Intraocular pressure 12 mmHg (pneumatic tonometry). 76 years old. Non-mydriatic. Axial length 21.93 mm. Autorefraction: sphere +3.75 D, cylinder -3 D, axis 95°: 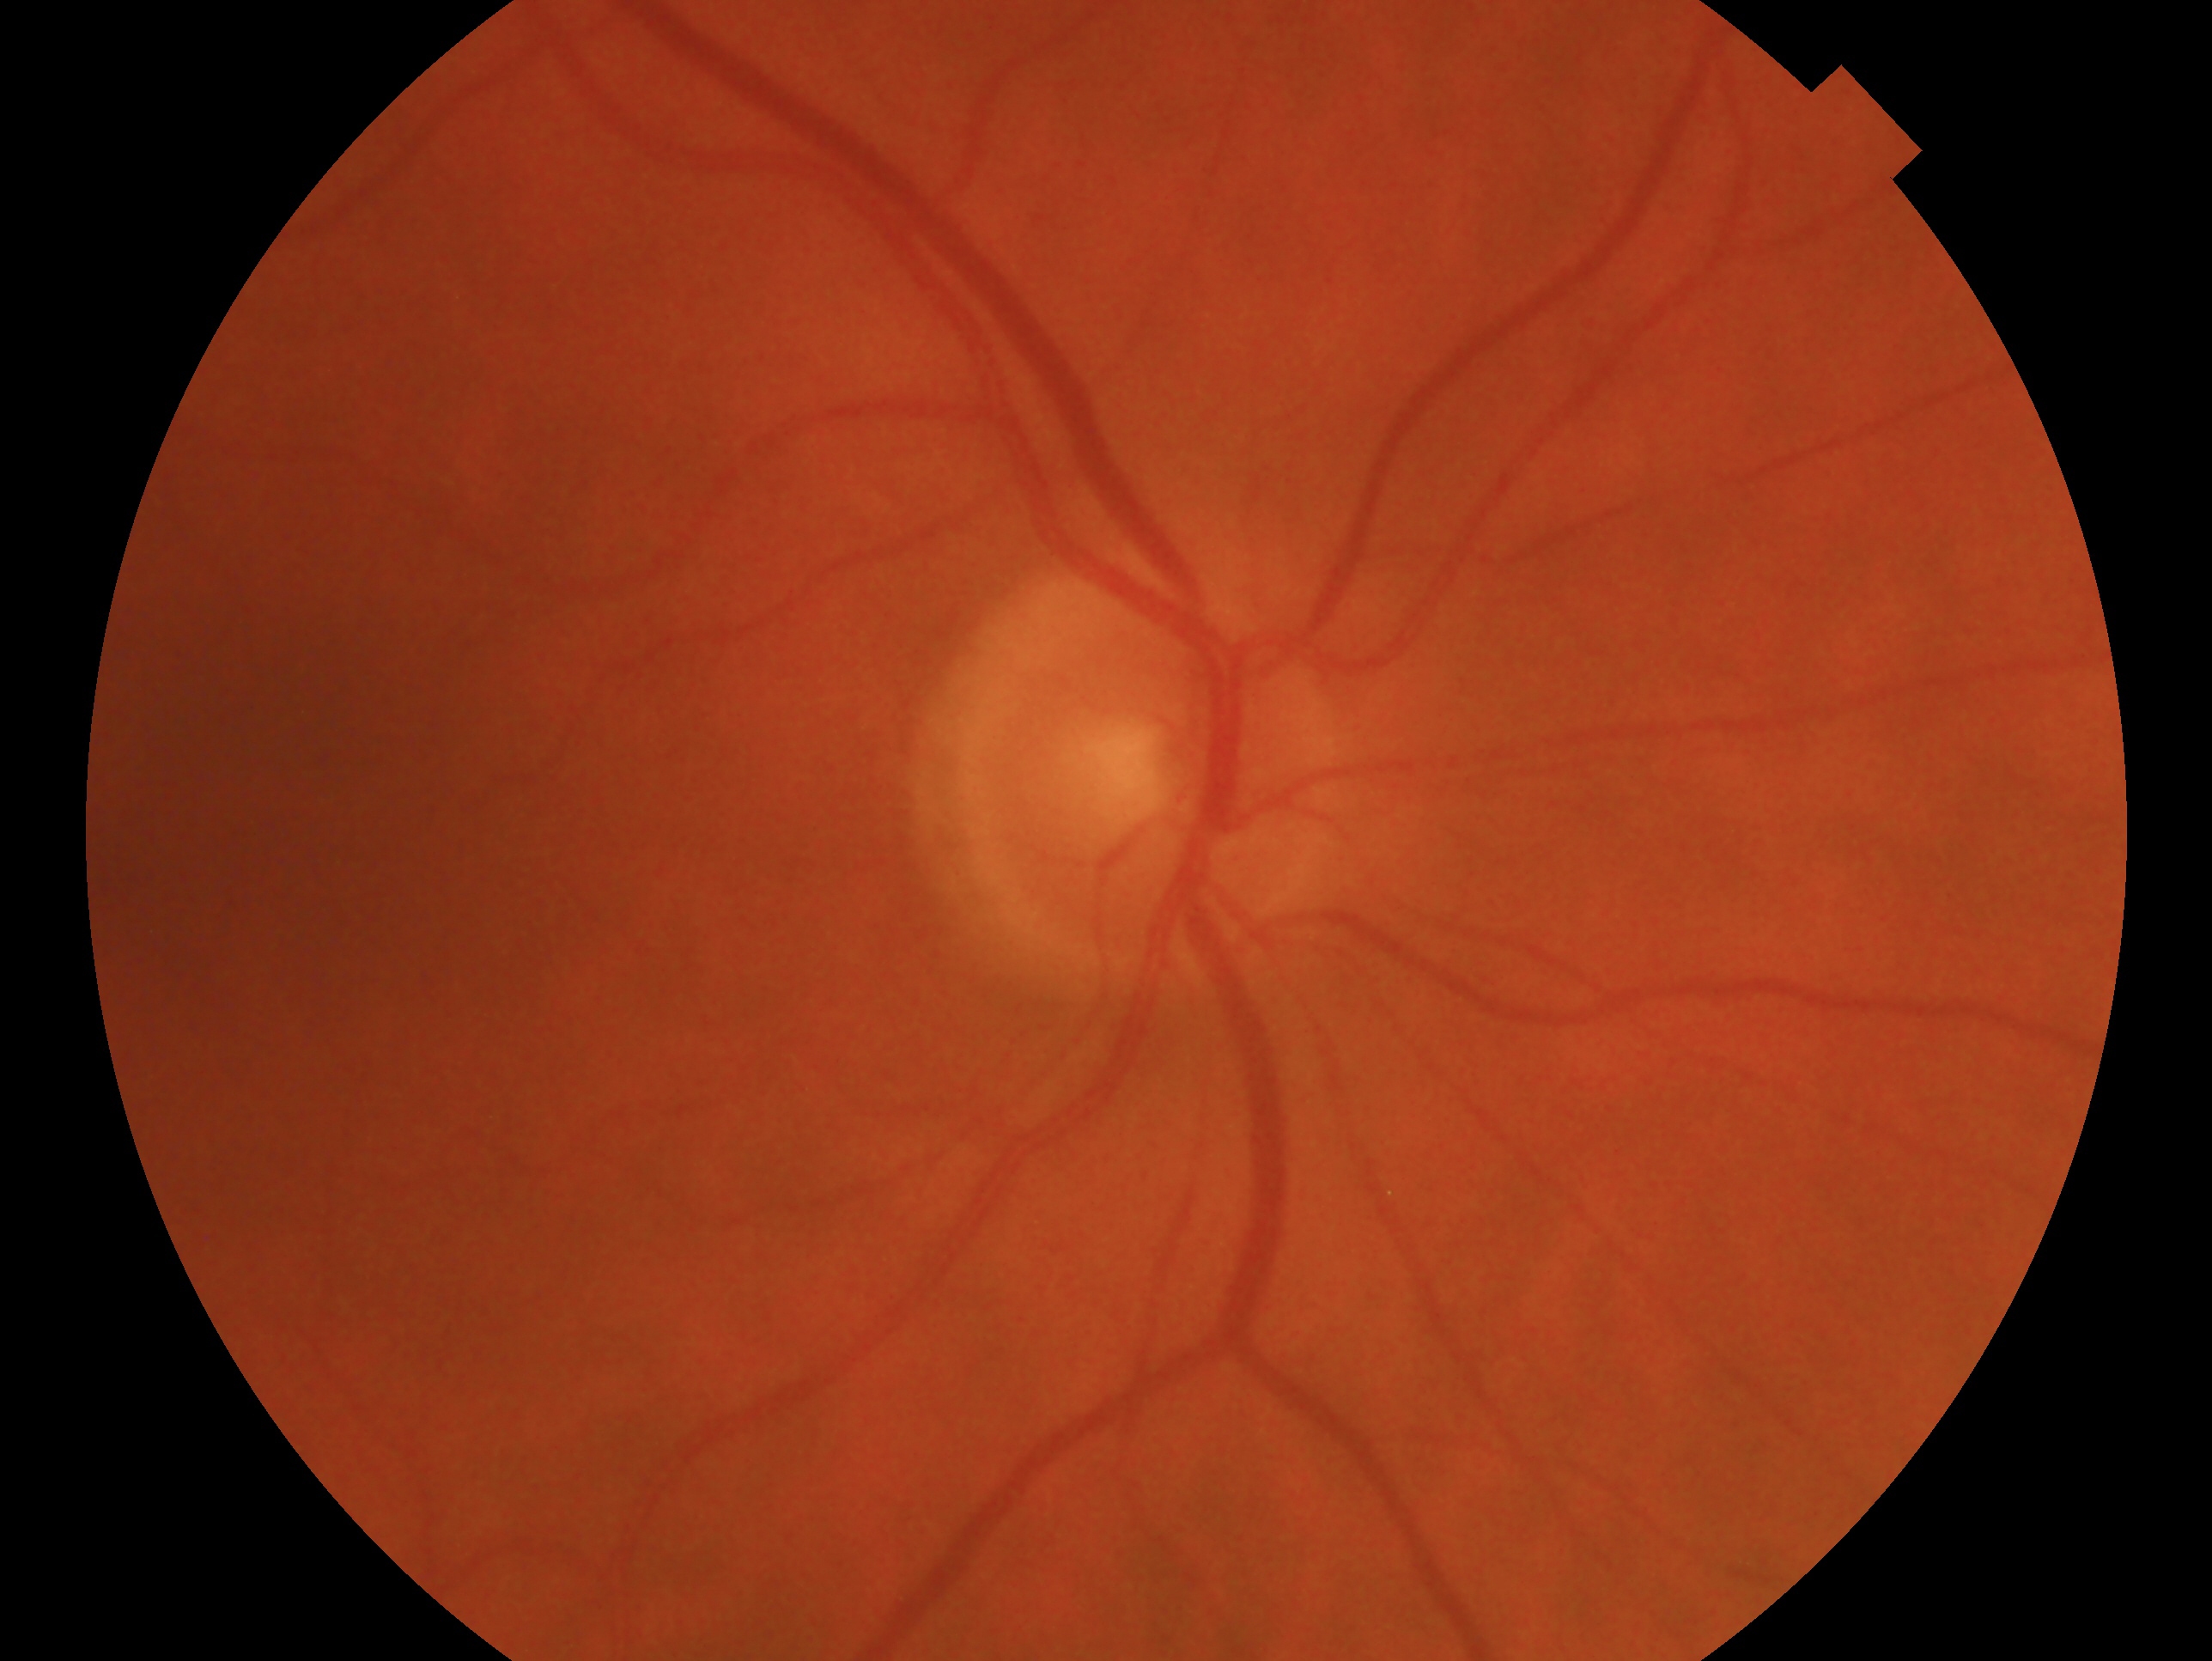 Q: Right or left eye?
A: right eye
Q: Glaucoma assessment?
A: no evidence of glaucoma